1440x1080px · wide-field fundus image from infant ROP screening:
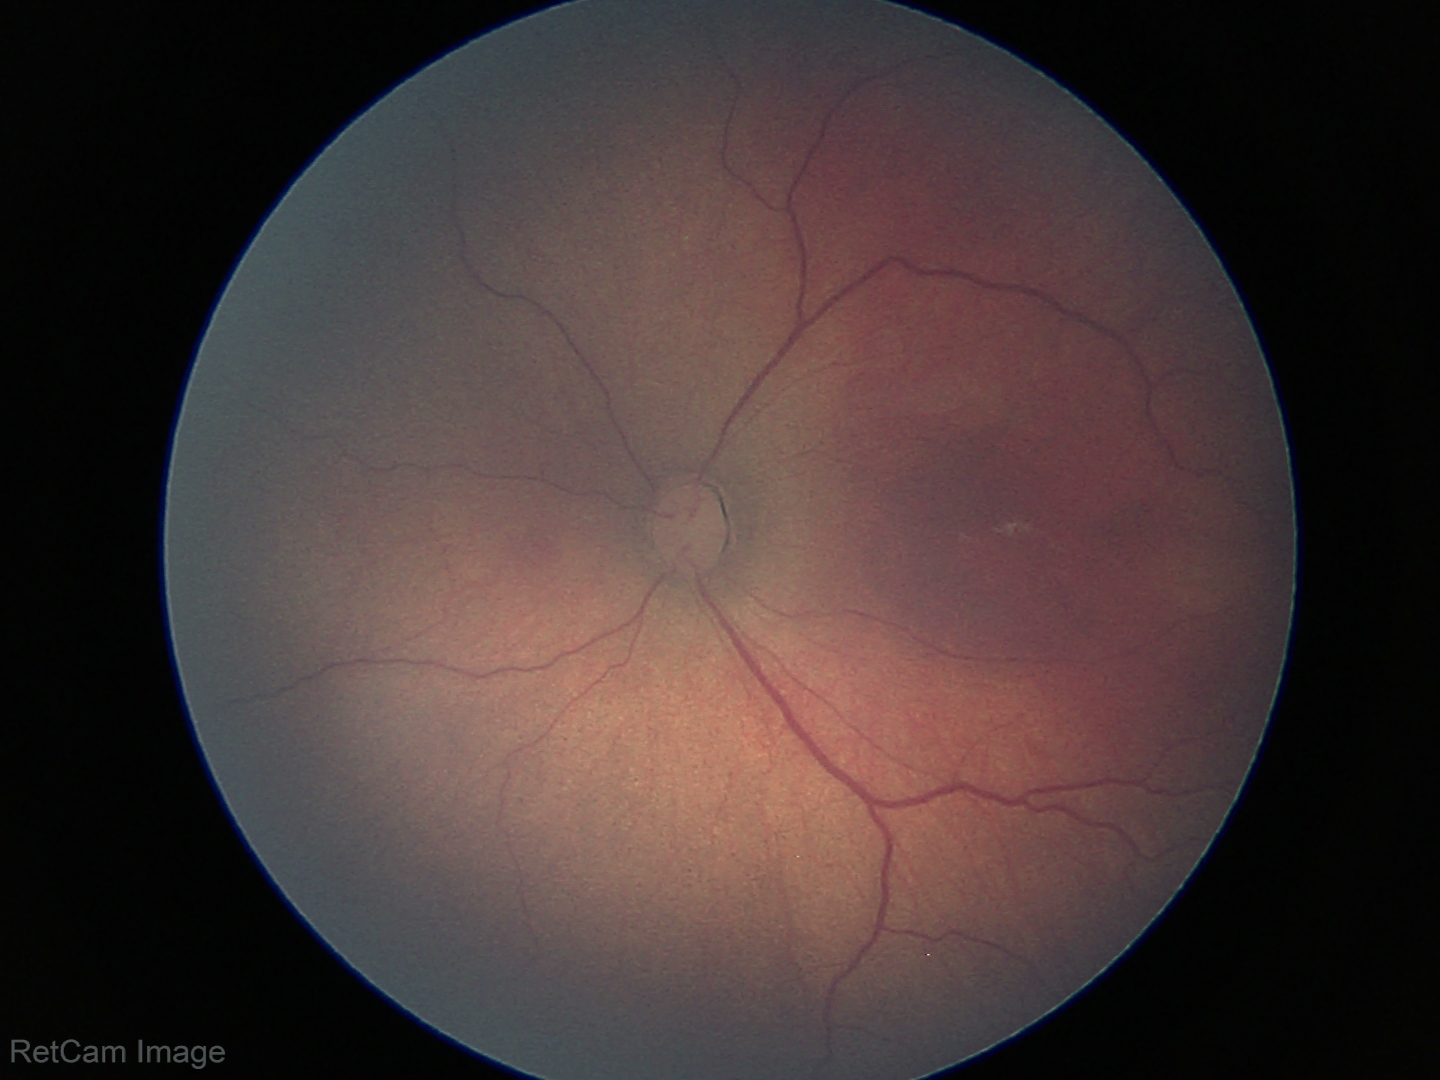 From an examination with diagnosis of retinopathy of prematurity stage 3. No plus disease.